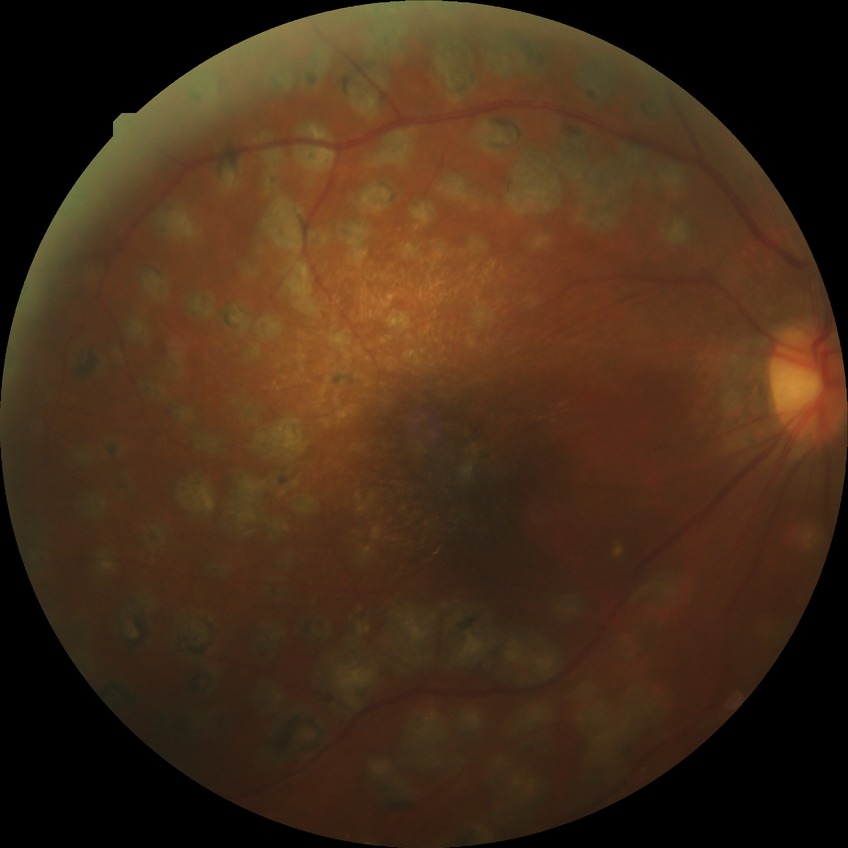 Diabetic retinopathy grade: proliferative diabetic retinopathy.